Color fundus image · 2352 by 1568 pixels · 45° FOV — 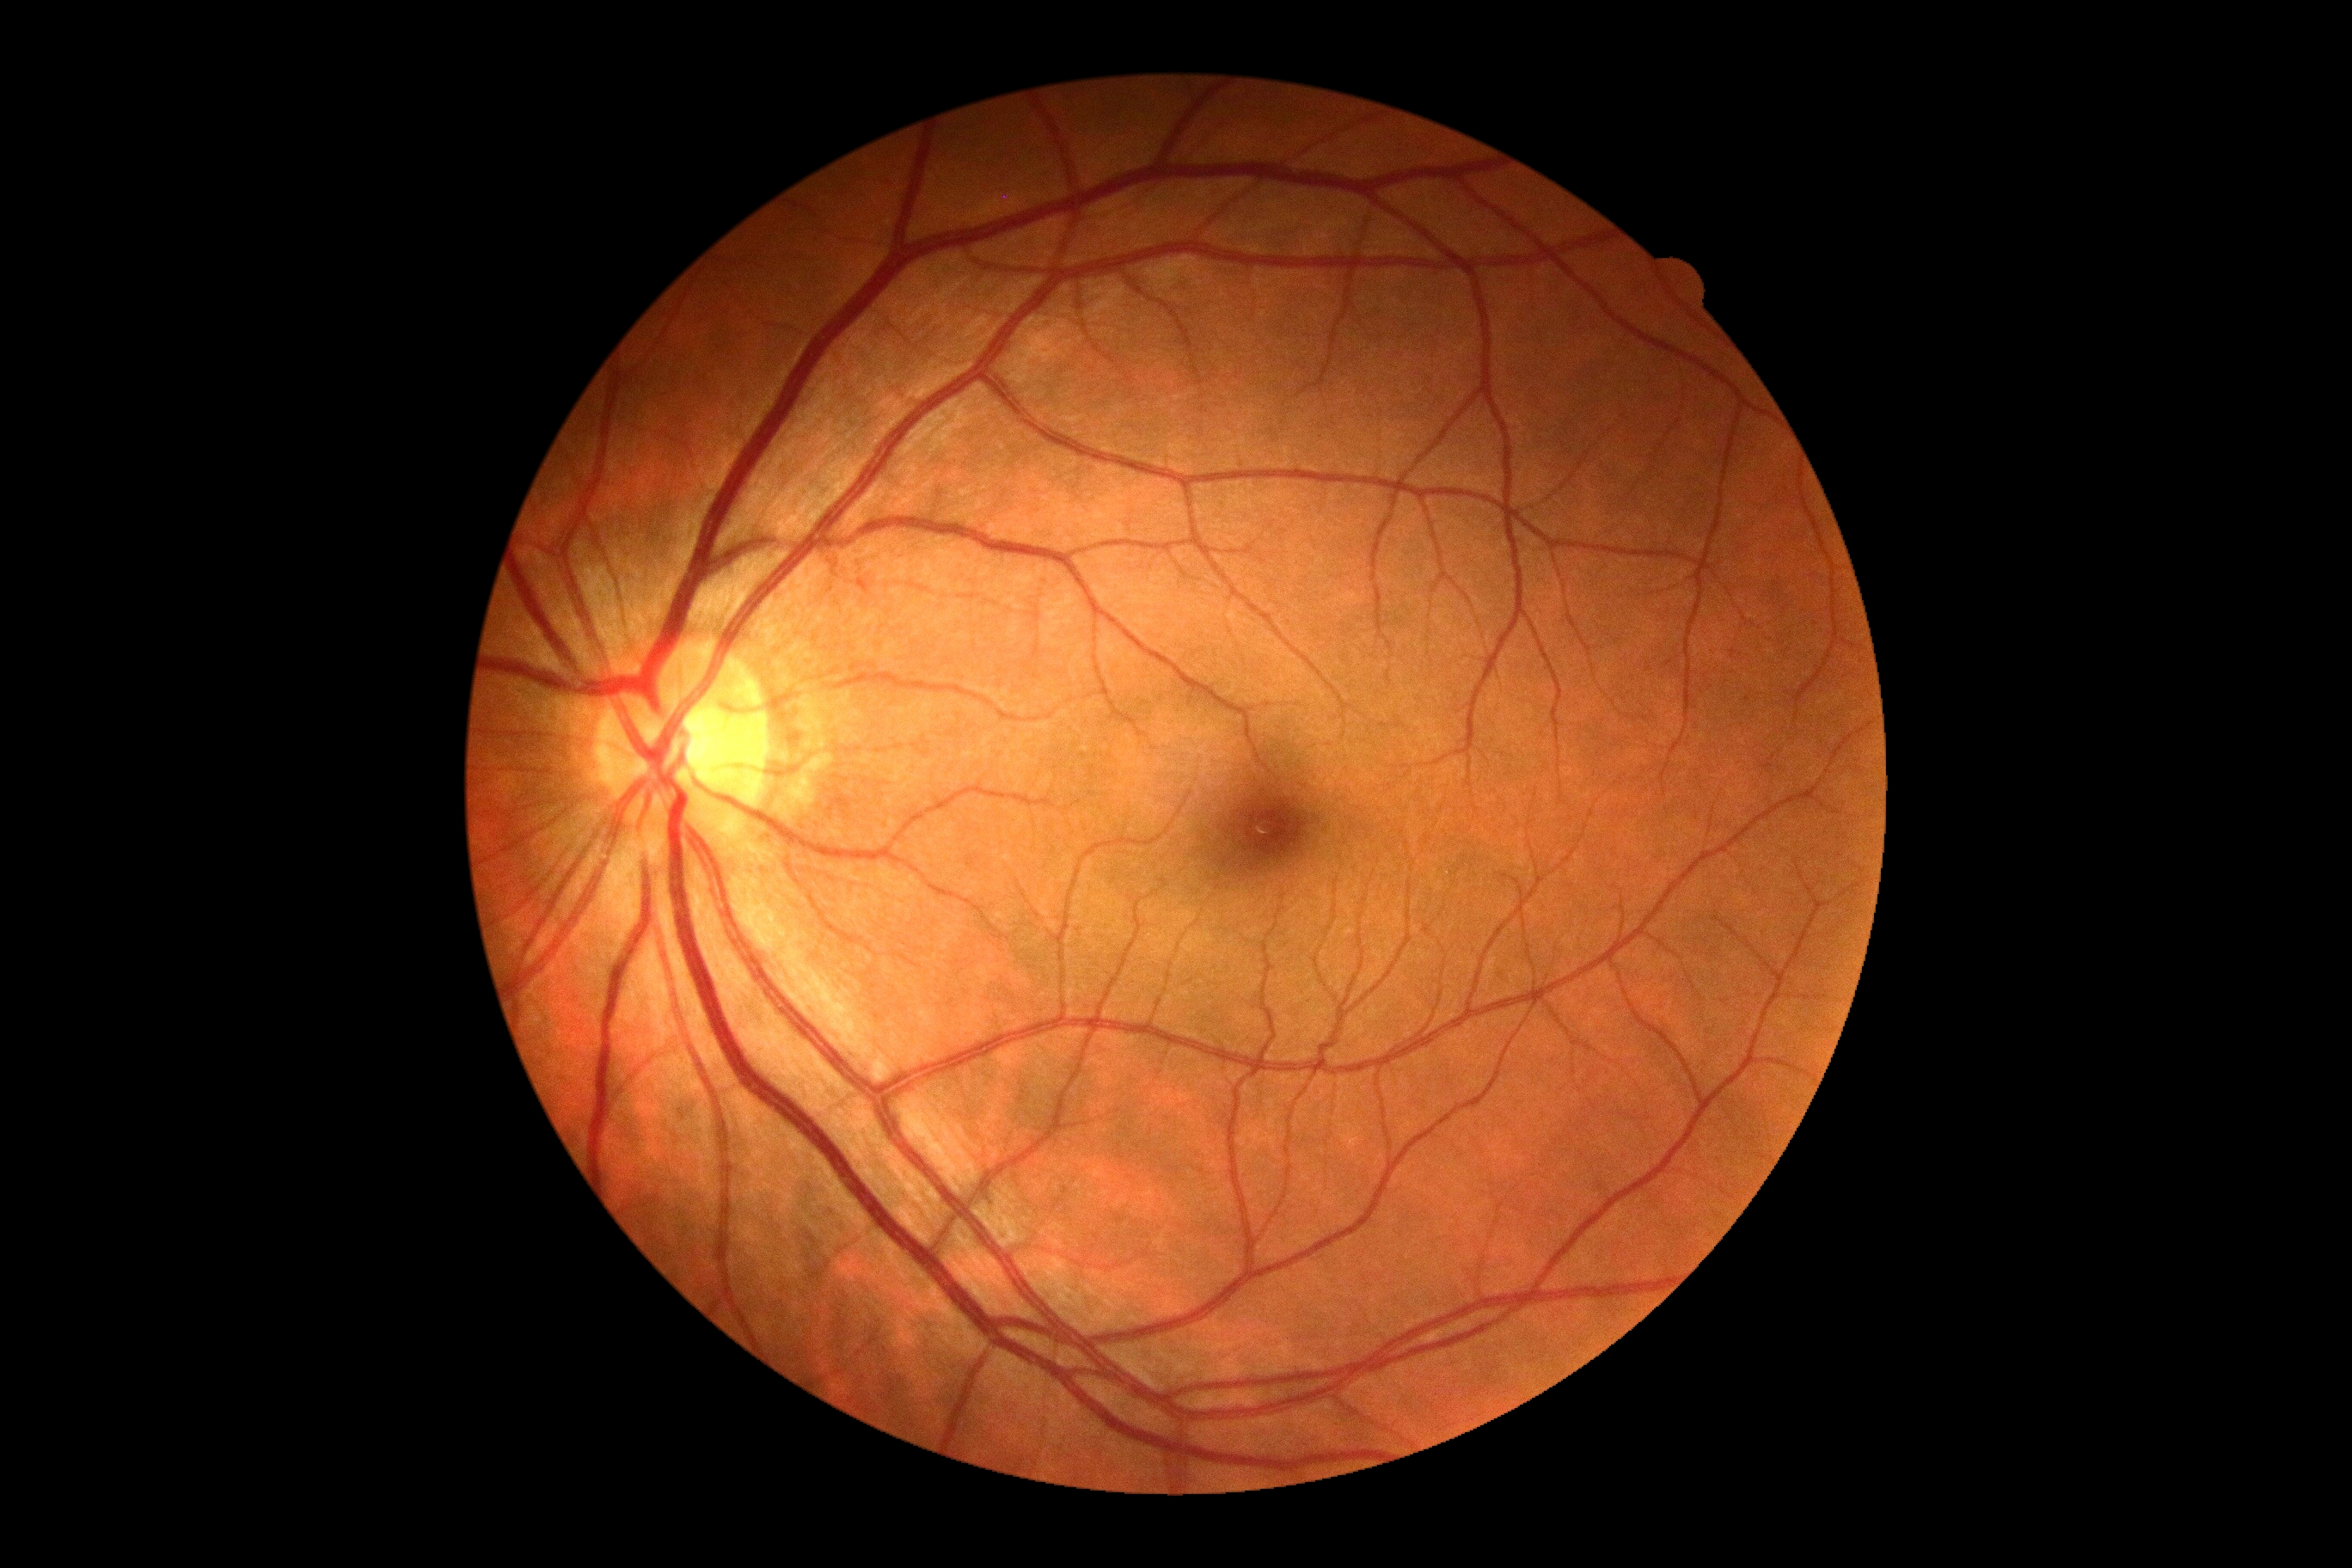 Diabetic retinopathy: grade 0 (no apparent retinopathy) — no visible signs of diabetic retinopathy.